Retinal fundus photograph:
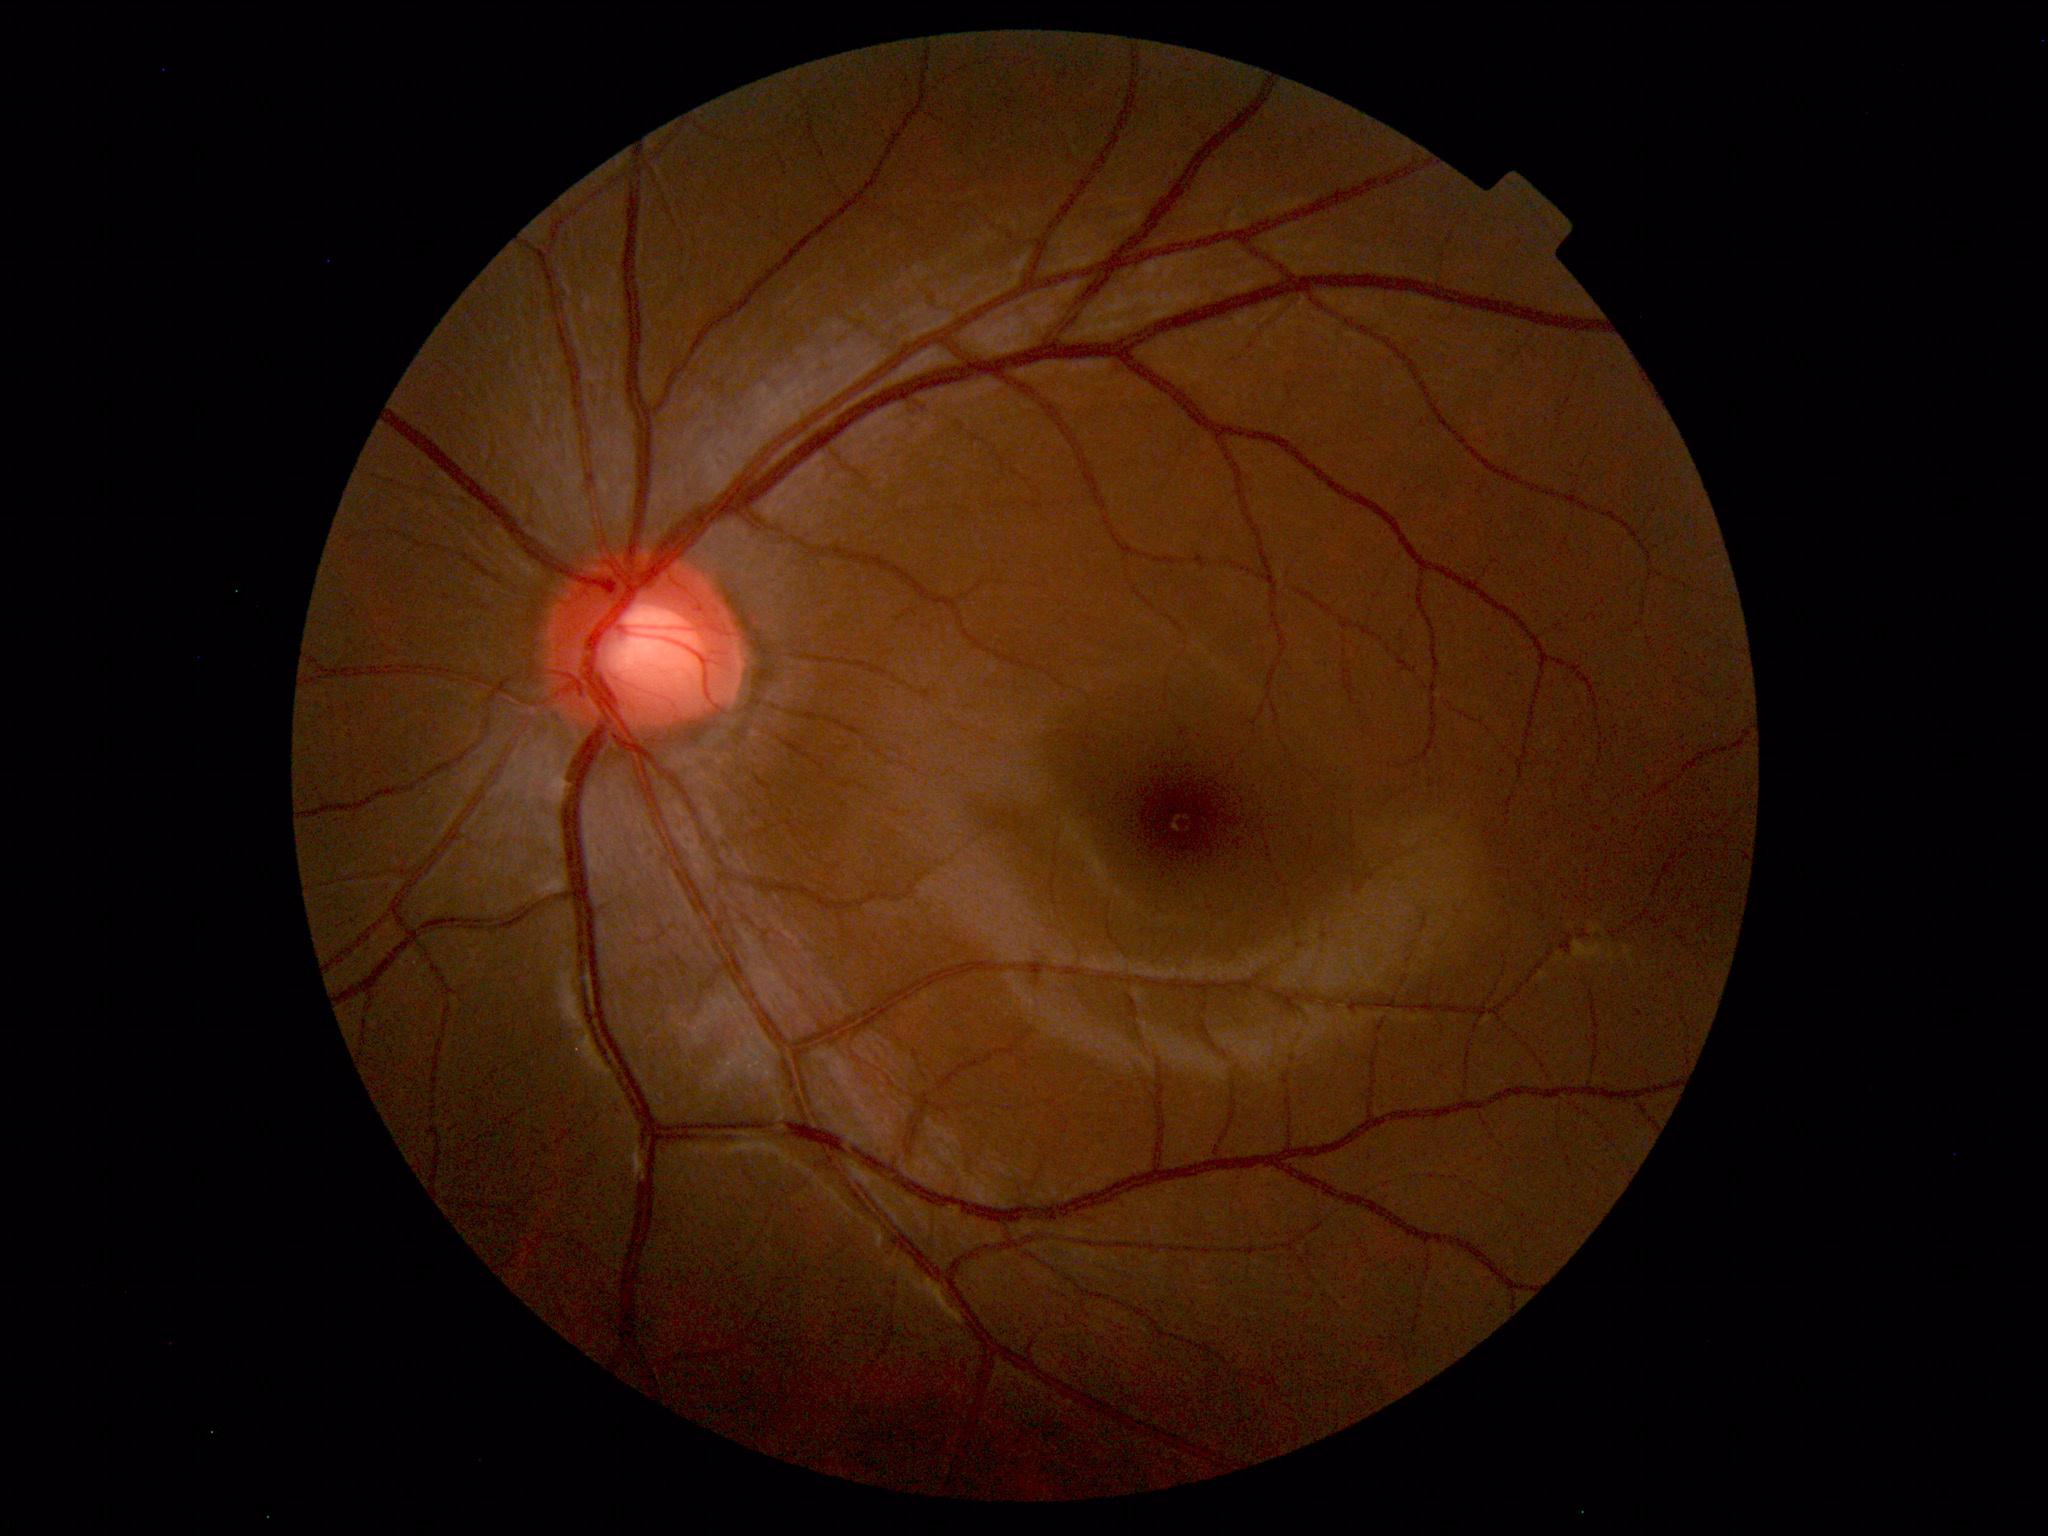

Findings: no abnormalities.